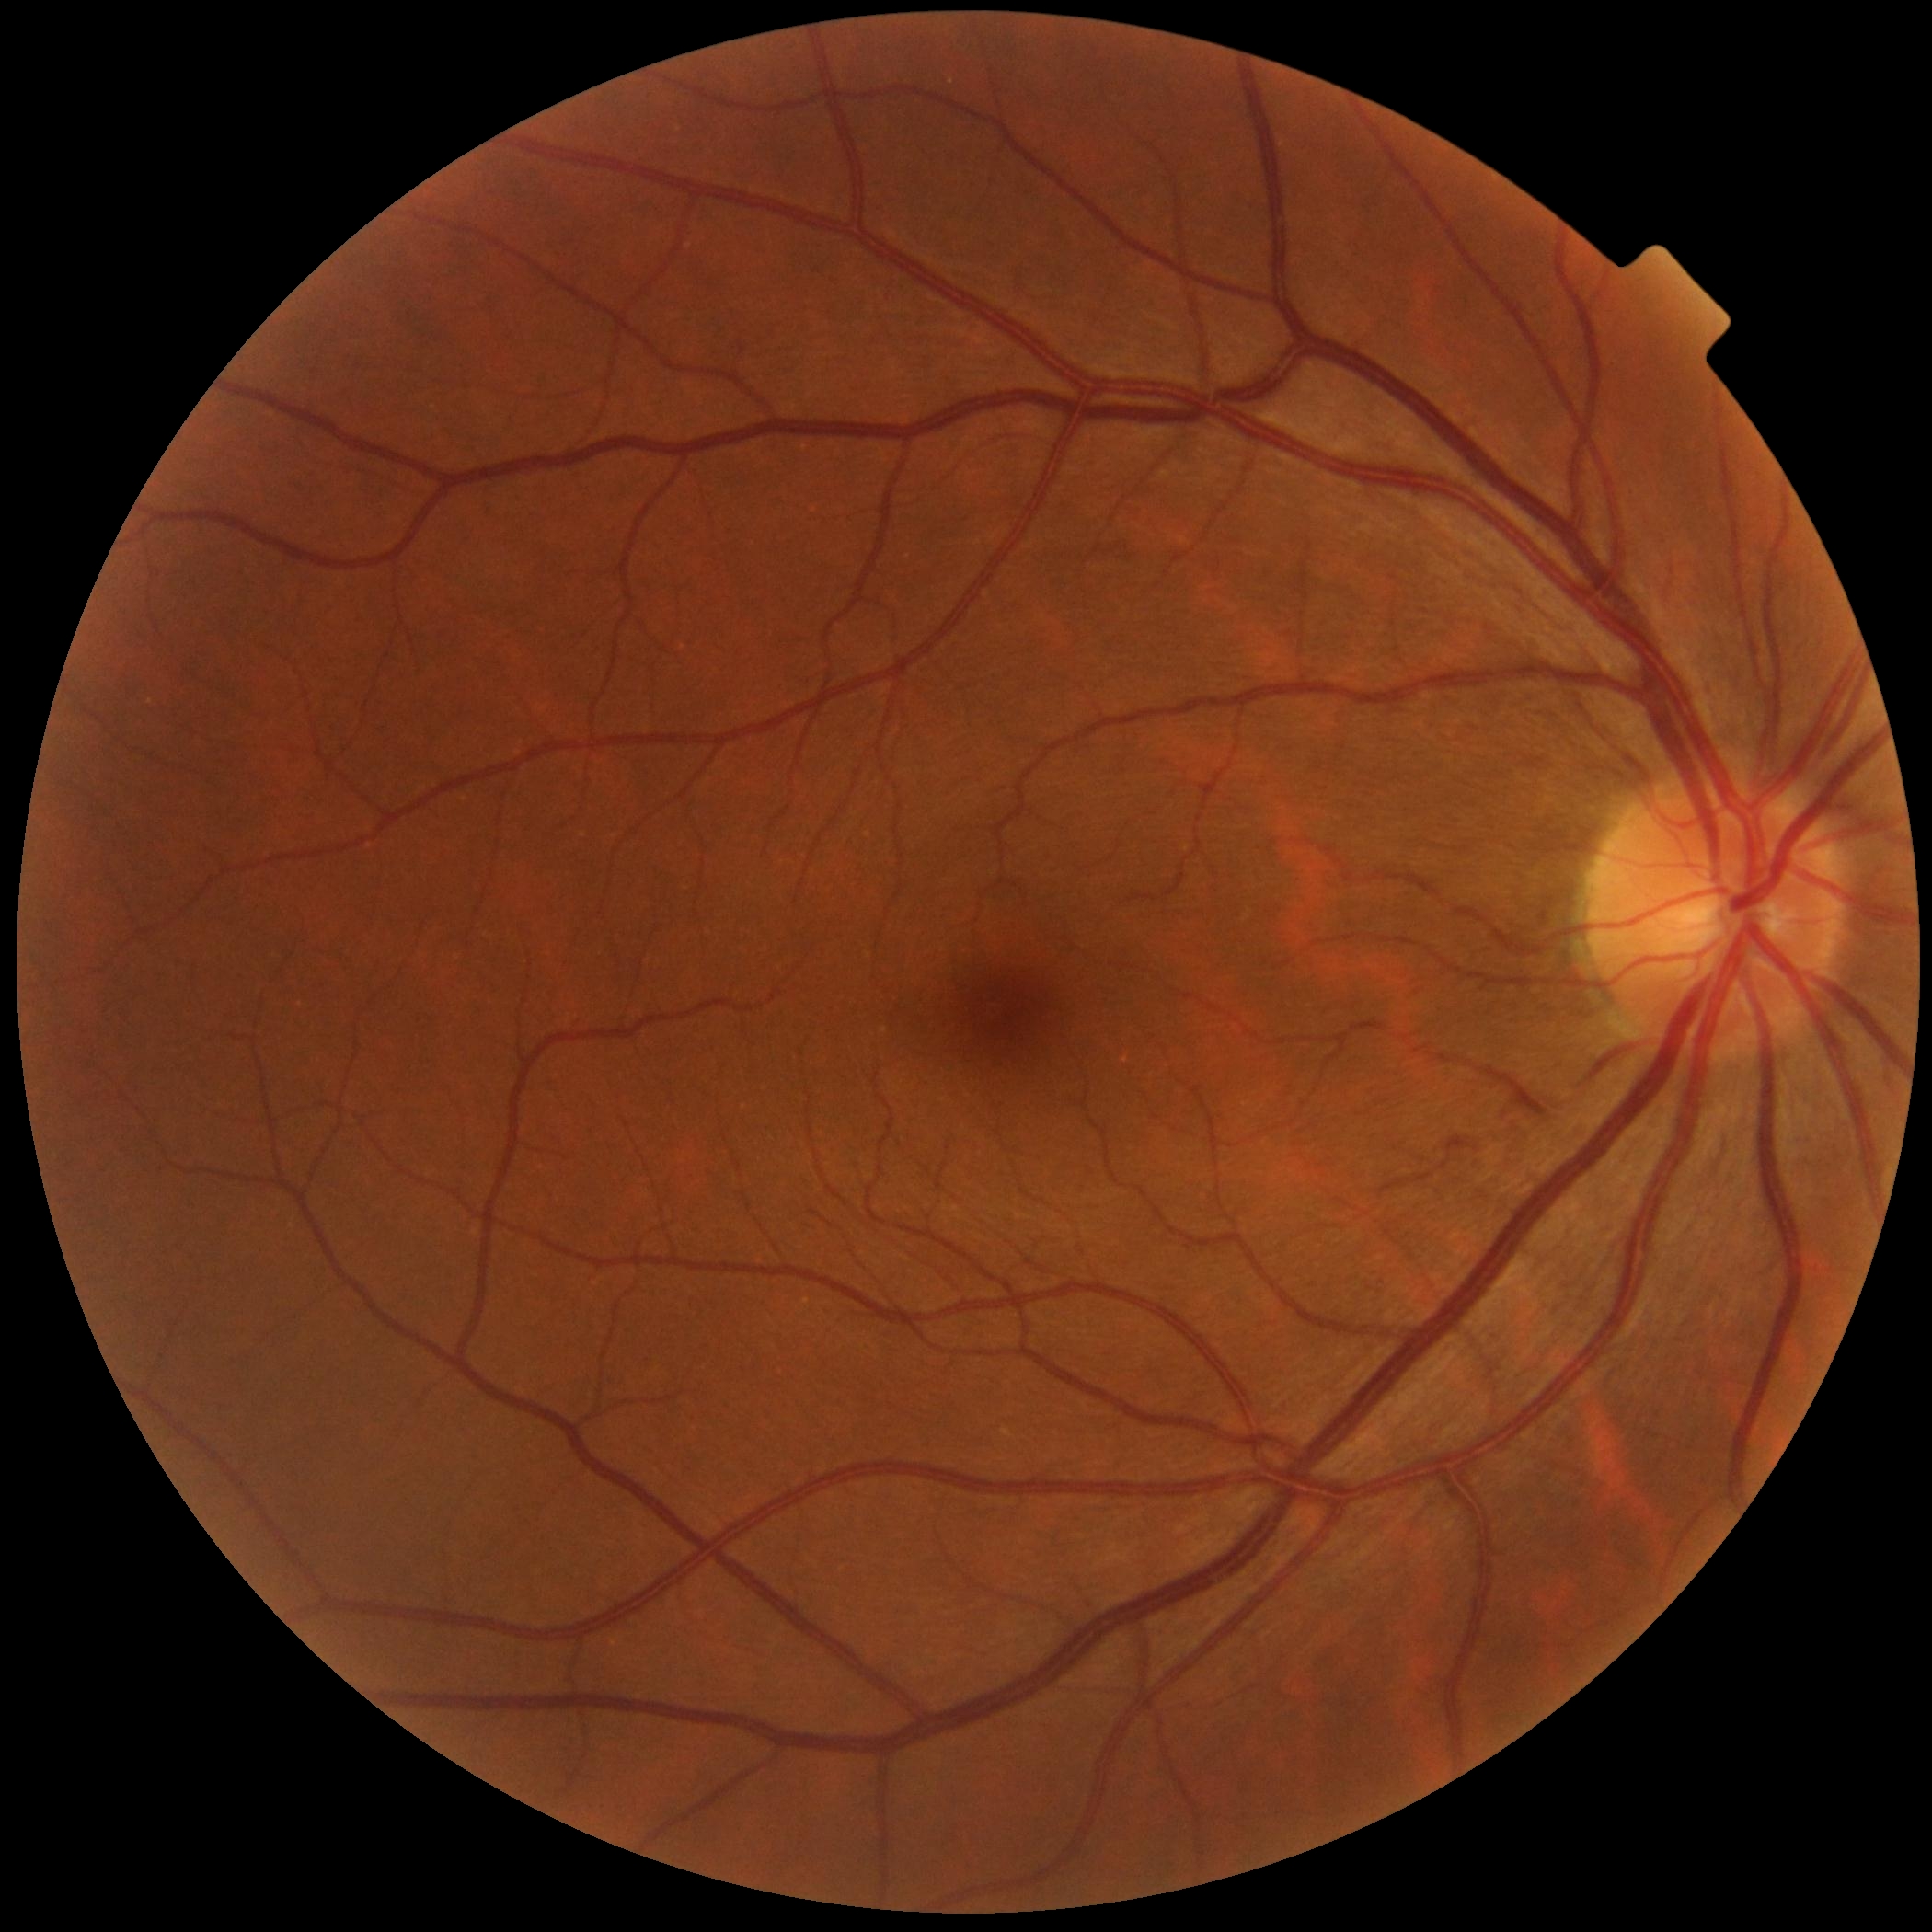 DR: no apparent diabetic retinopathy (grade 0).